CFP · NIDEK AFC-230 fundus camera · nonmydriatic fundus photograph · 45° field of view · 848 by 848 pixels:
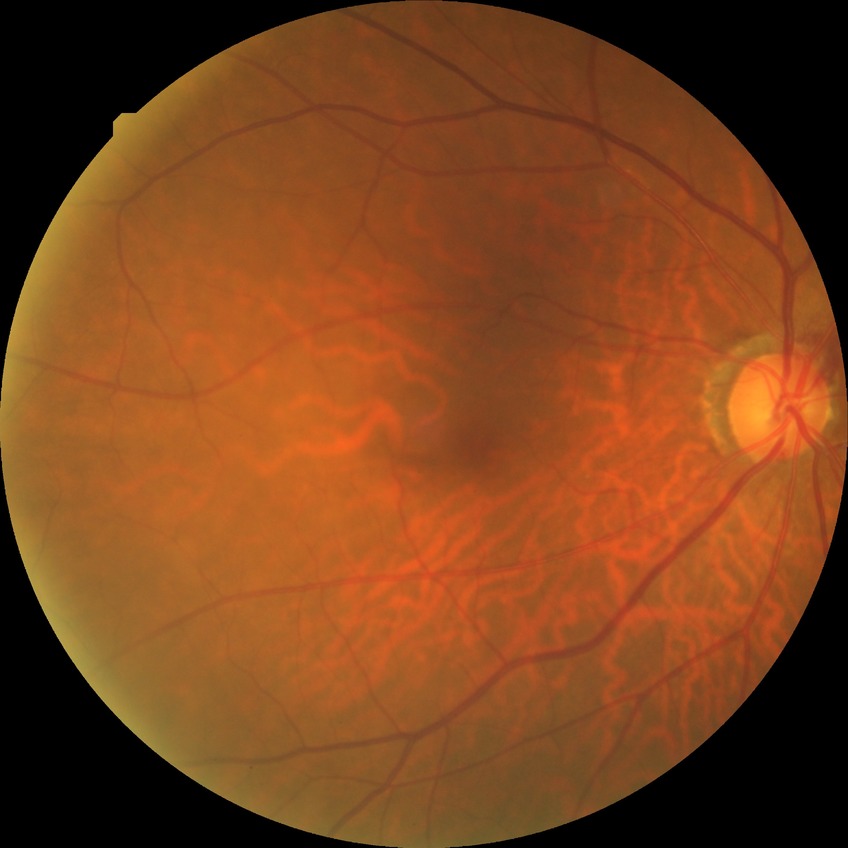

Modified Davis classification is no diabetic retinopathy.